Diabetic retinopathy graded by the modified Davis classification: 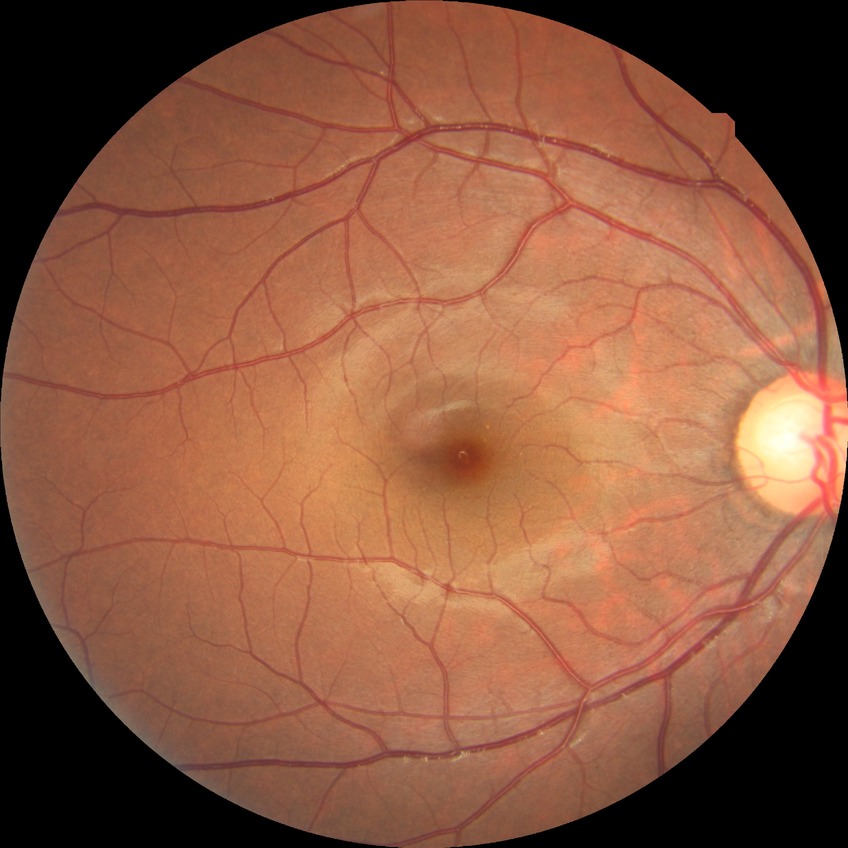
Diabetic retinopathy (DR) is no diabetic retinopathy (NDR).